Color fundus image · 45° field of view · 1932 by 1910 pixels:
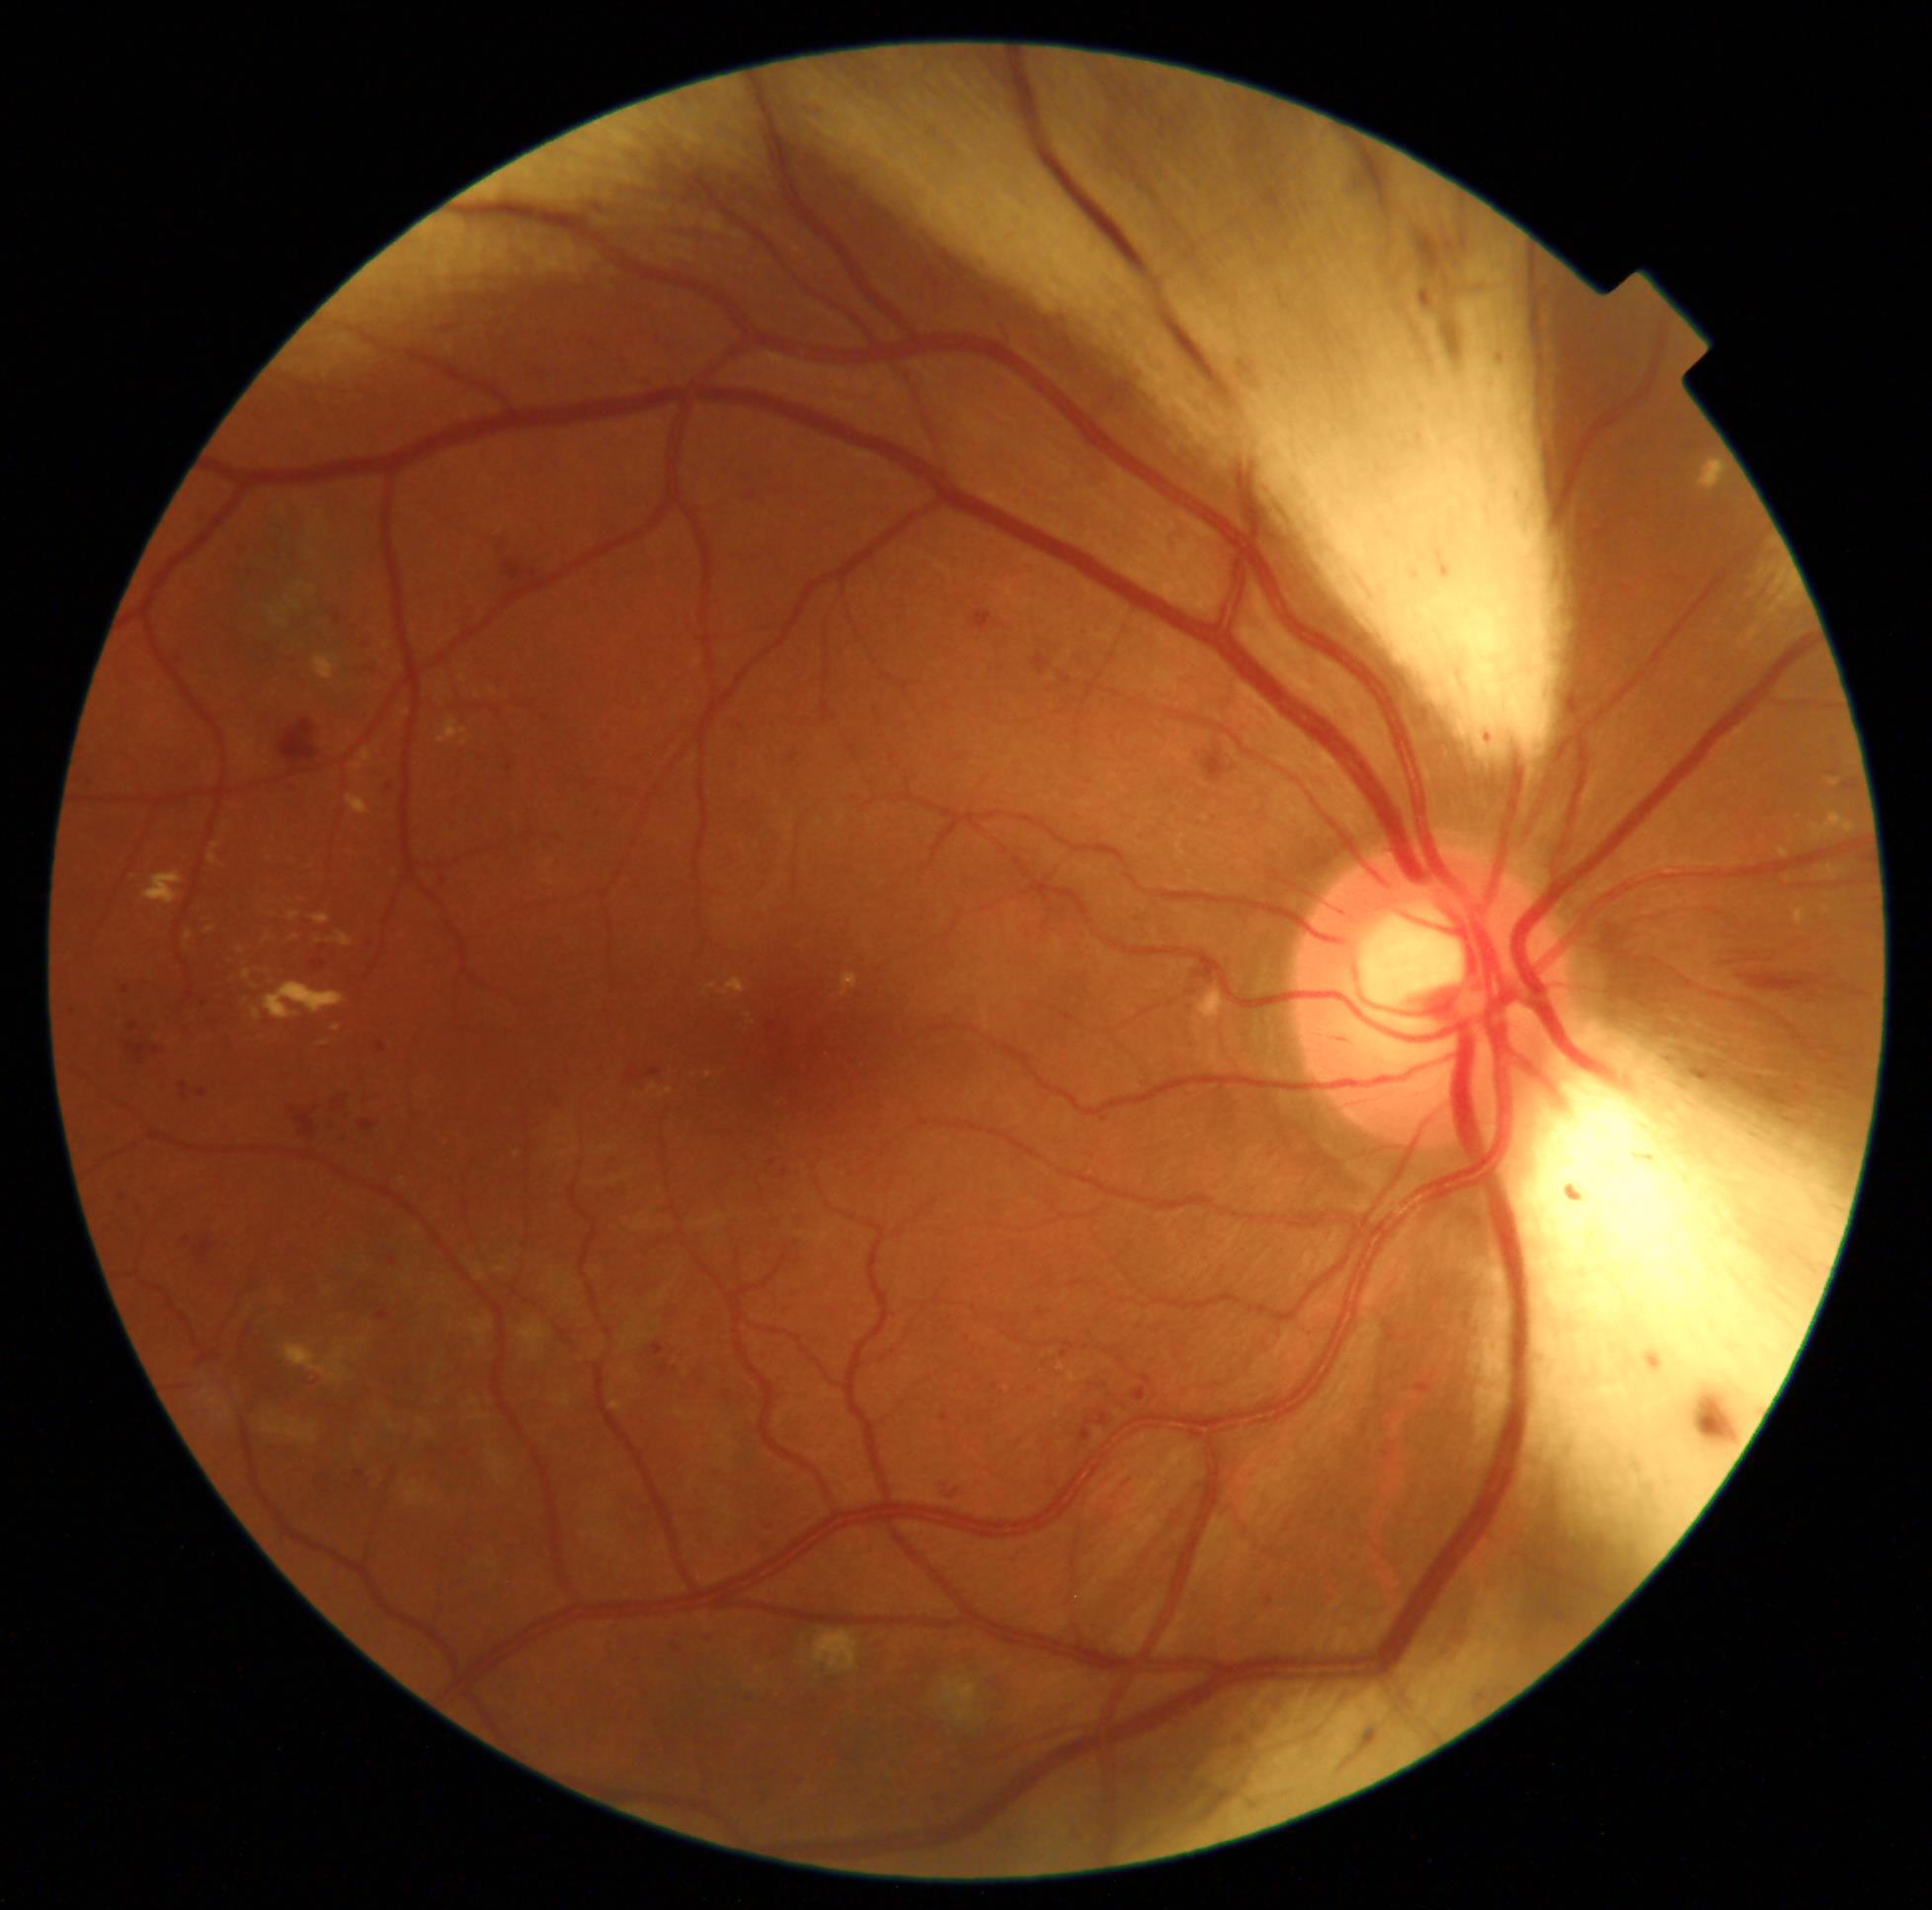 DR severity is moderate NPDR (grade 2).